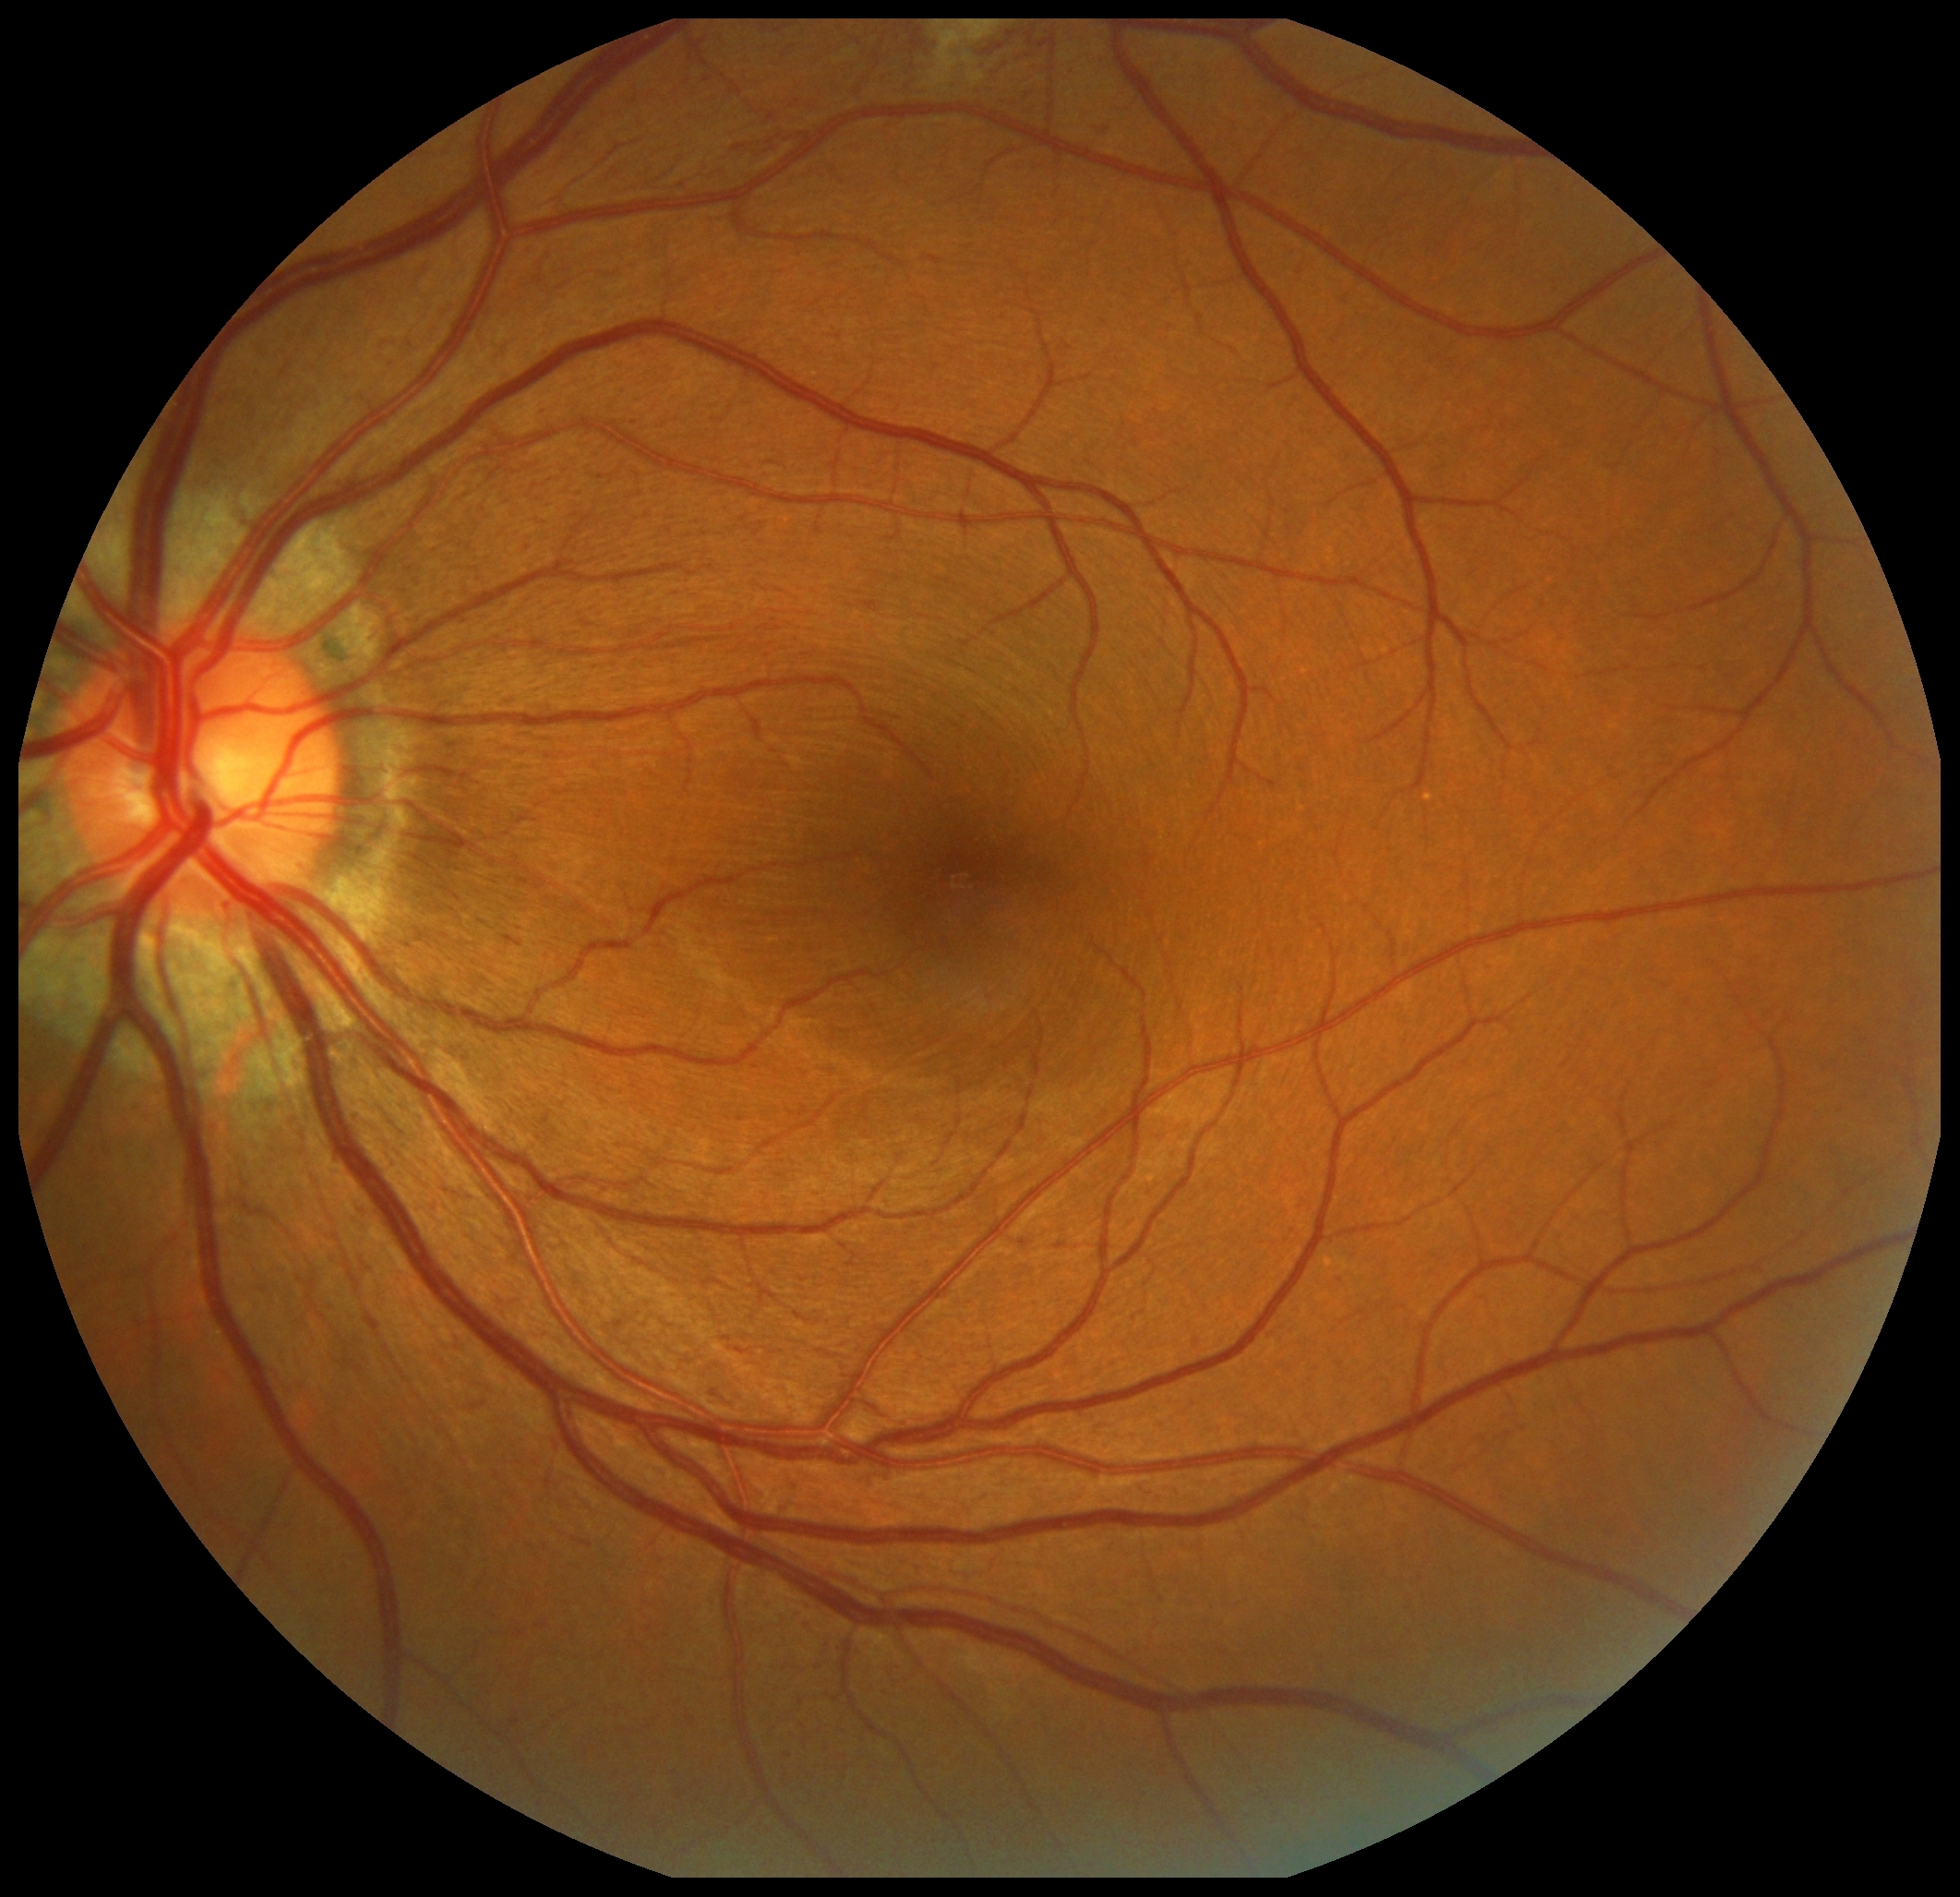
DR class = non-proliferative diabetic retinopathy
retinopathy grade = 2/4